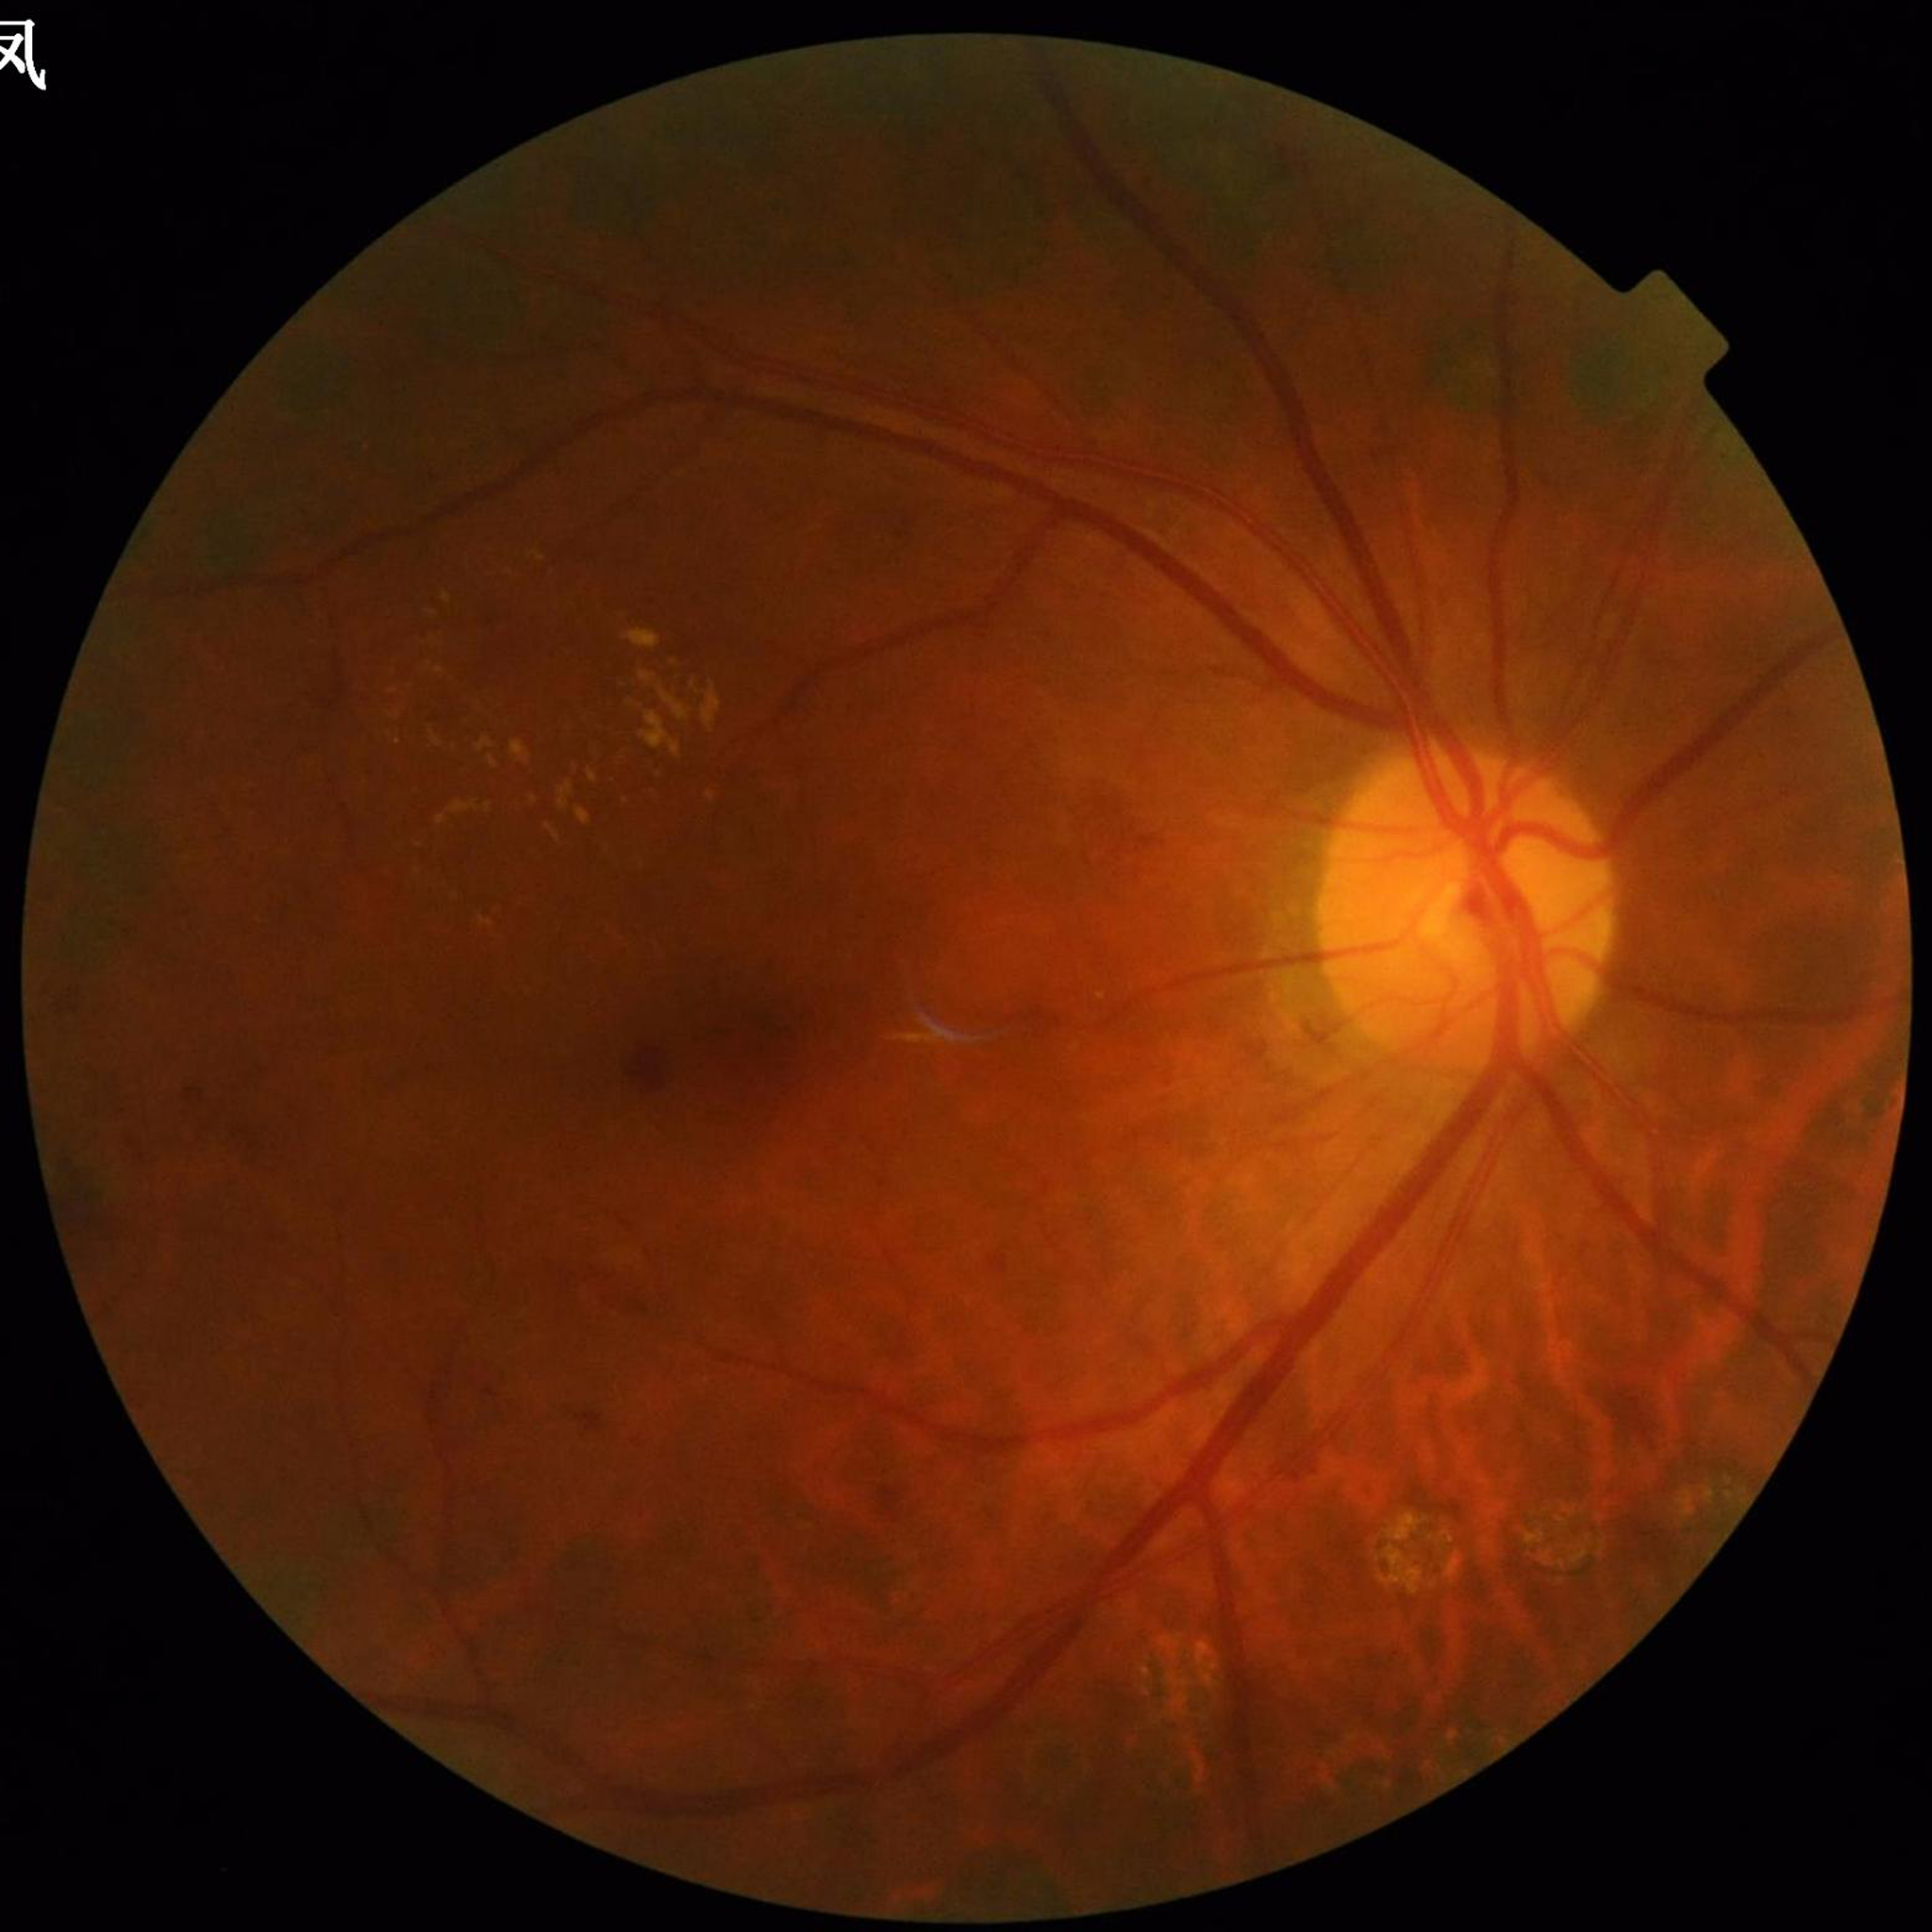
Clinical diagnosis = diabetic retinopathy.